Modified Davis classification — 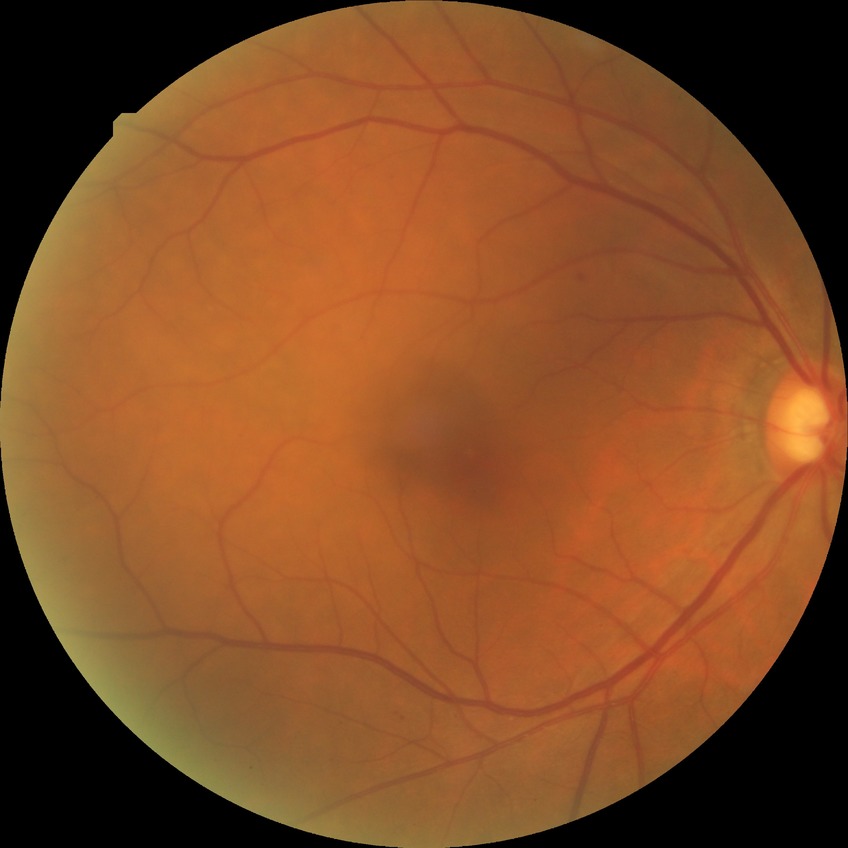 Diabetic retinopathy (DR) is SDR (simple diabetic retinopathy).